45-degree field of view; 2352 by 1568 pixels; CFP — 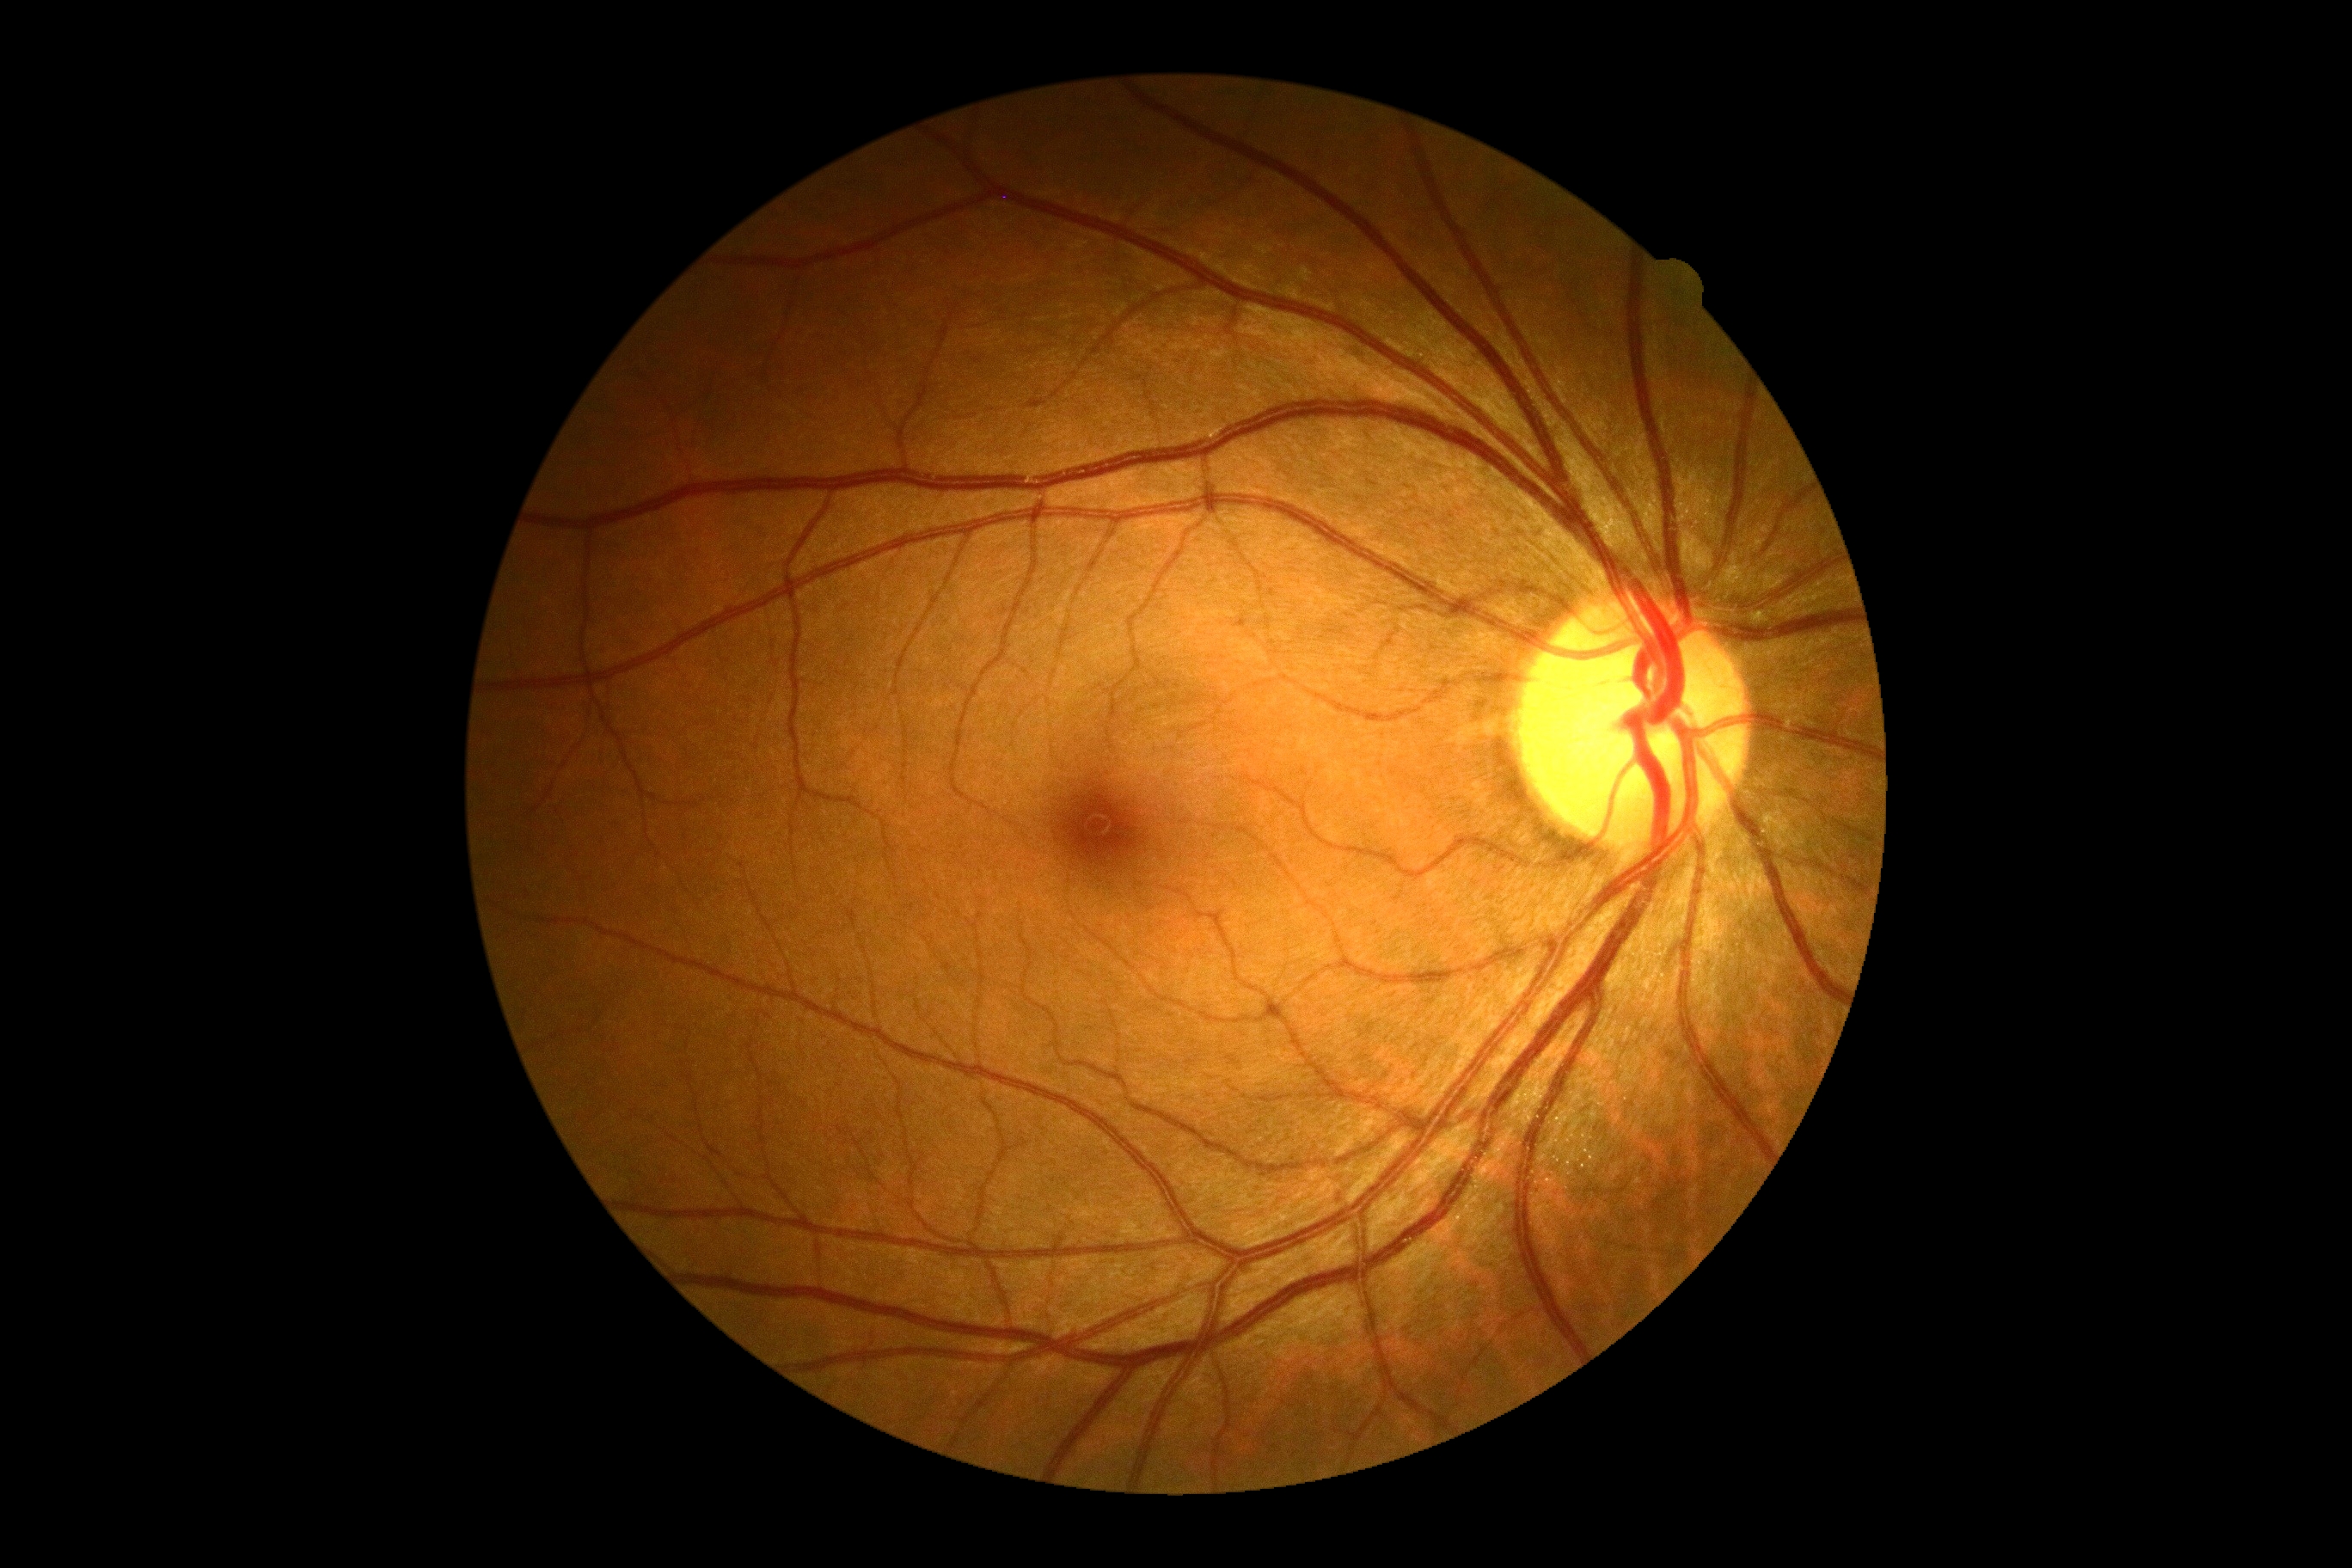

{"dr_grade": "grade 0 (no apparent retinopathy) — no visible signs of diabetic retinopathy", "dr_impression": "negative for DR"}